Modified Davis classification.
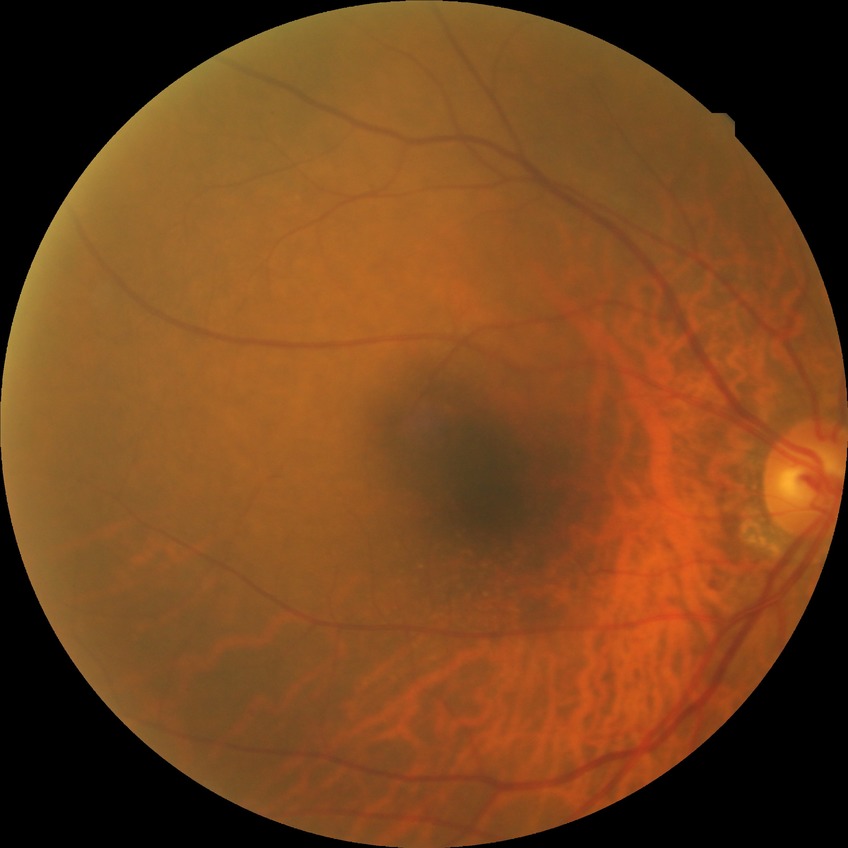

• retinopathy grade — no diabetic retinopathy